1380x1382 · 45° FOV · fundus photo
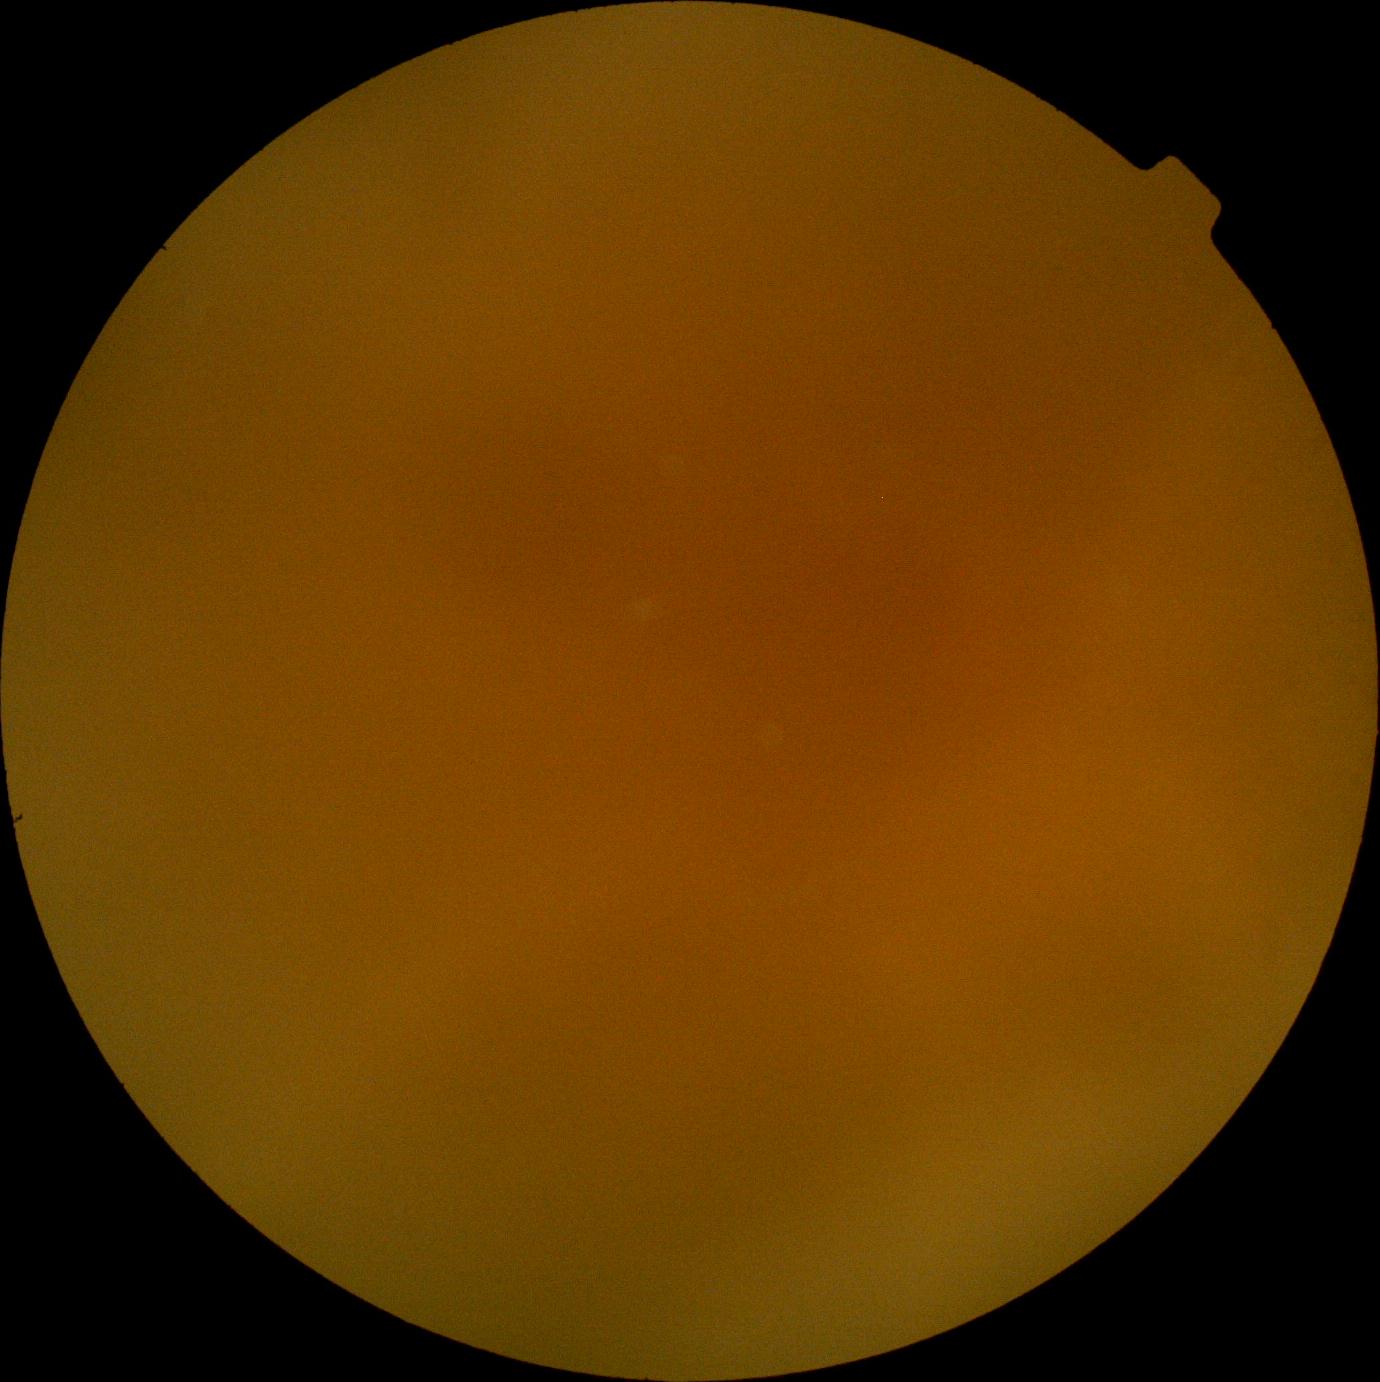 Ungradable image — DR severity cannot be determined. Diabetic retinopathy (DR): ungradable due to poor image quality.